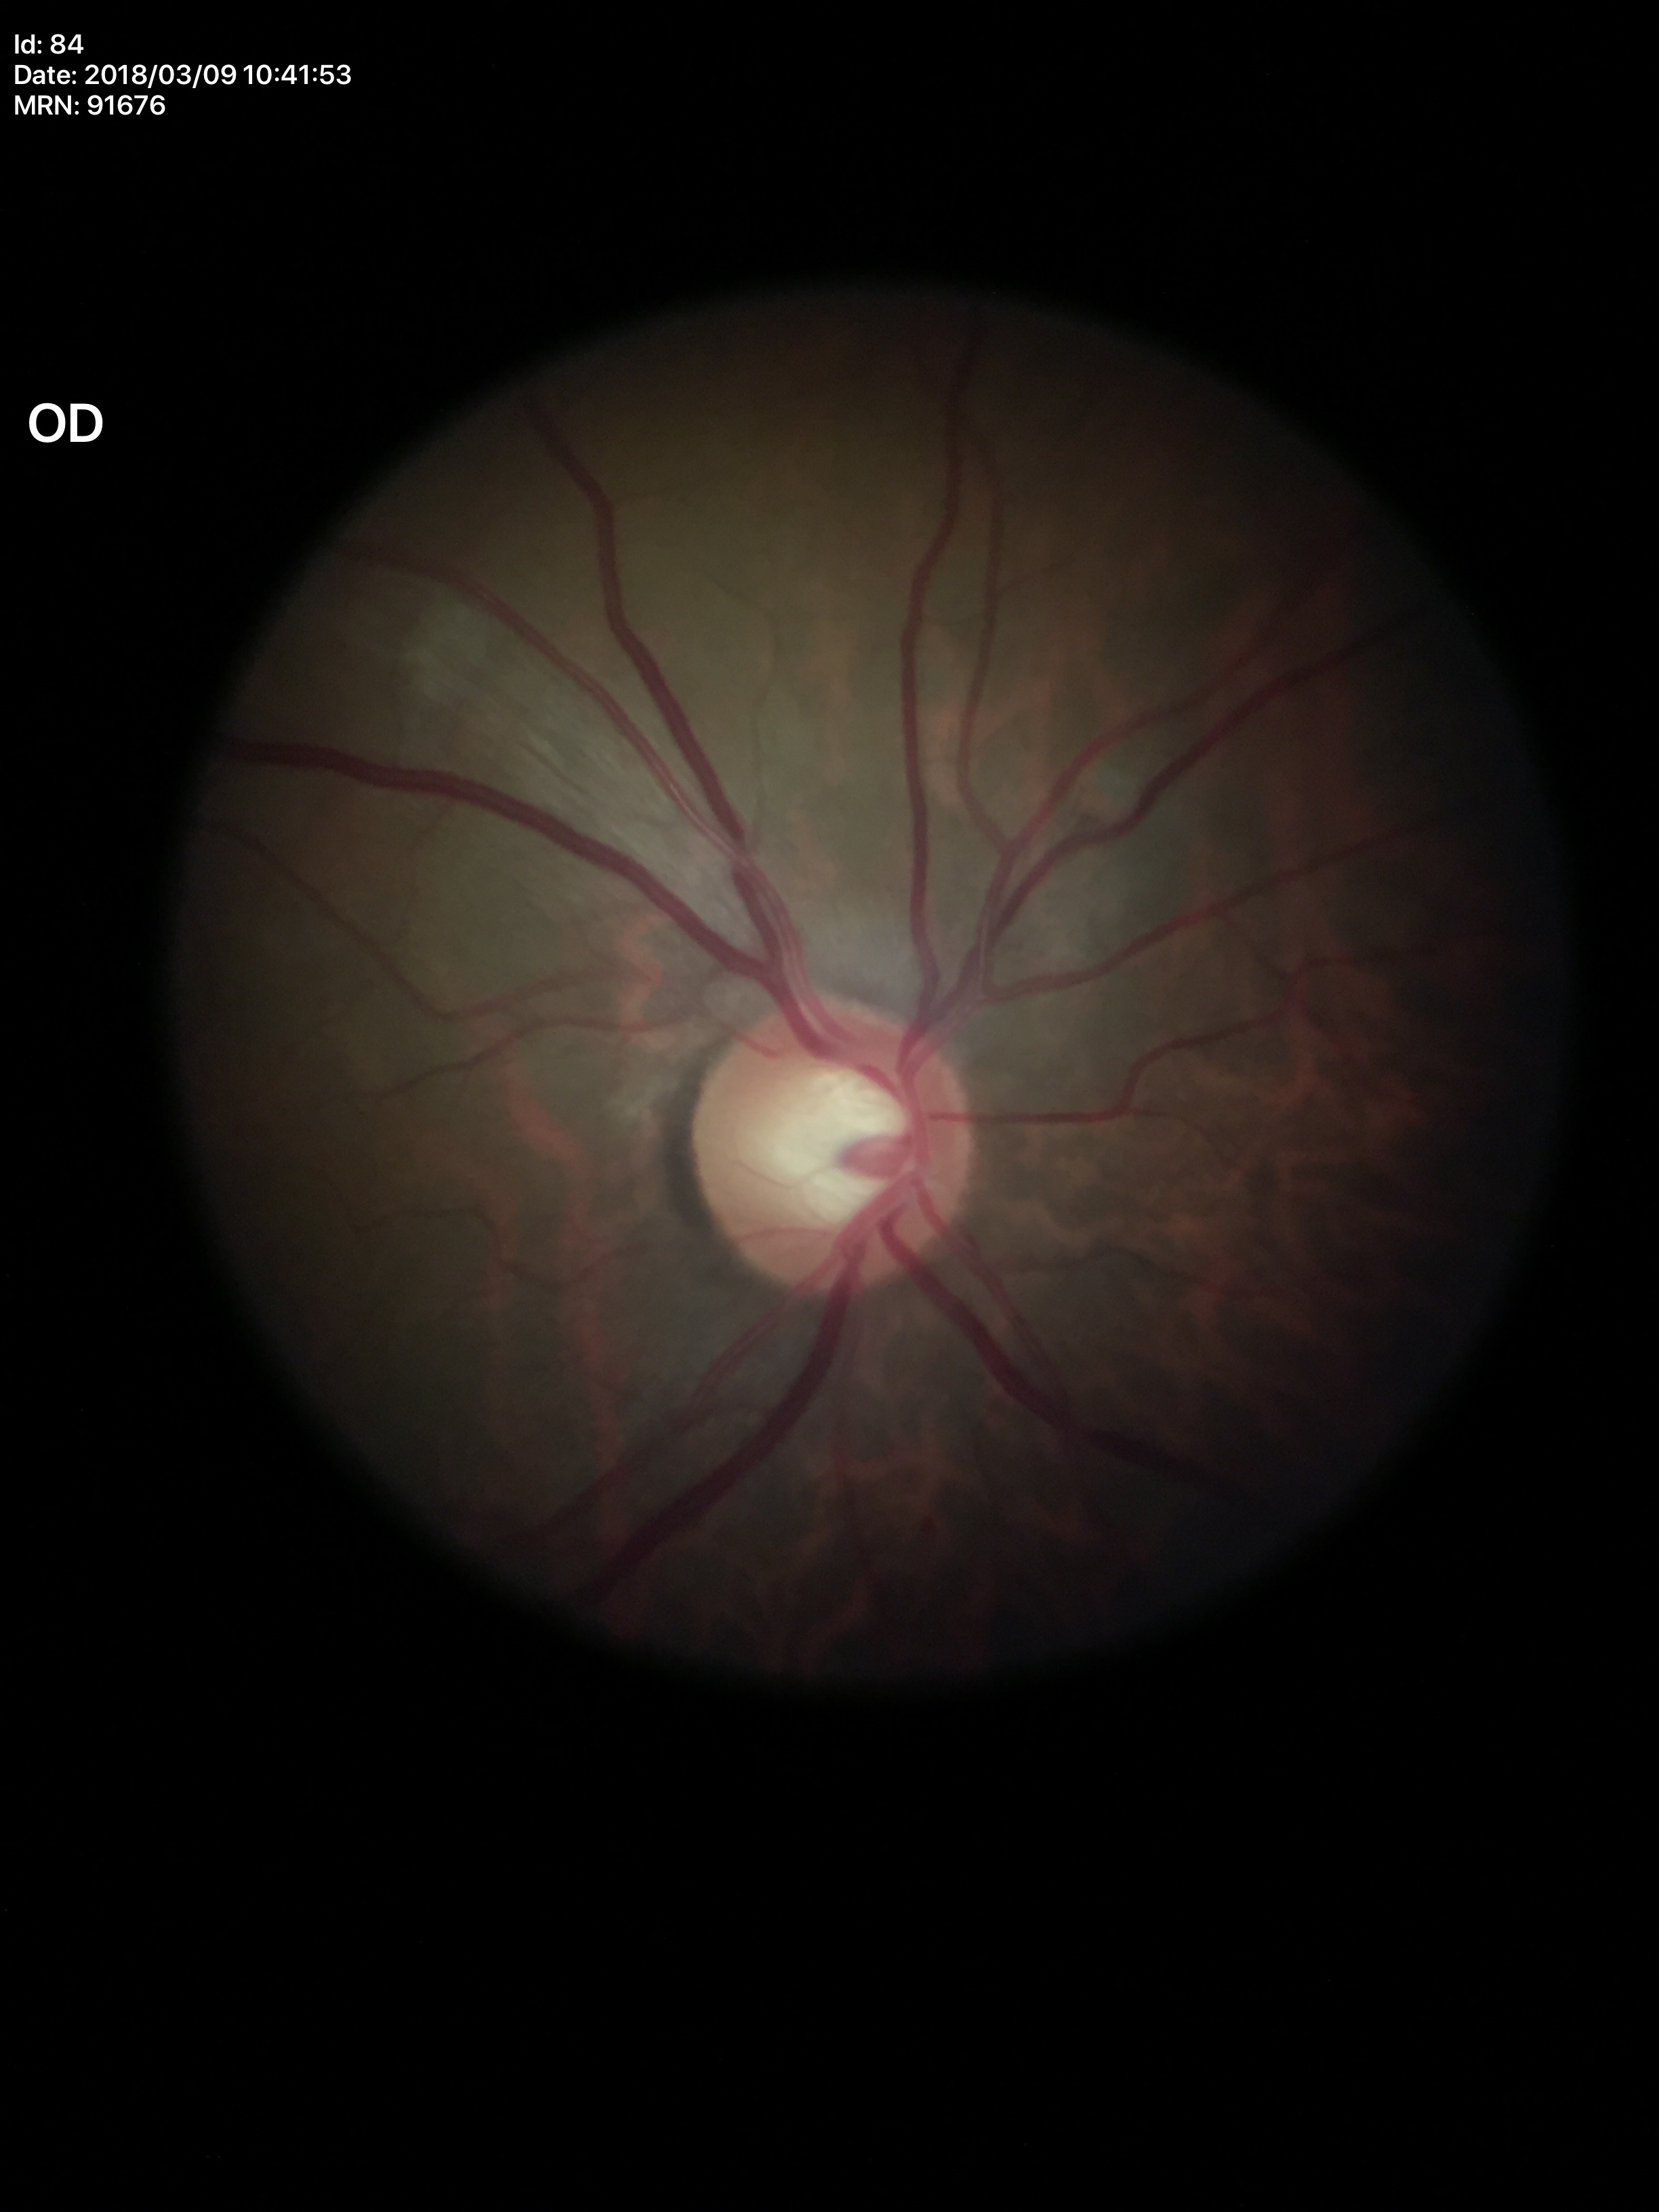

Glaucoma screening impression = suspicious (three of five ophthalmologists flagged glaucoma suspect); area cup-to-disc ratio = 0.37; vertical cup-to-disc ratio = 0.59.